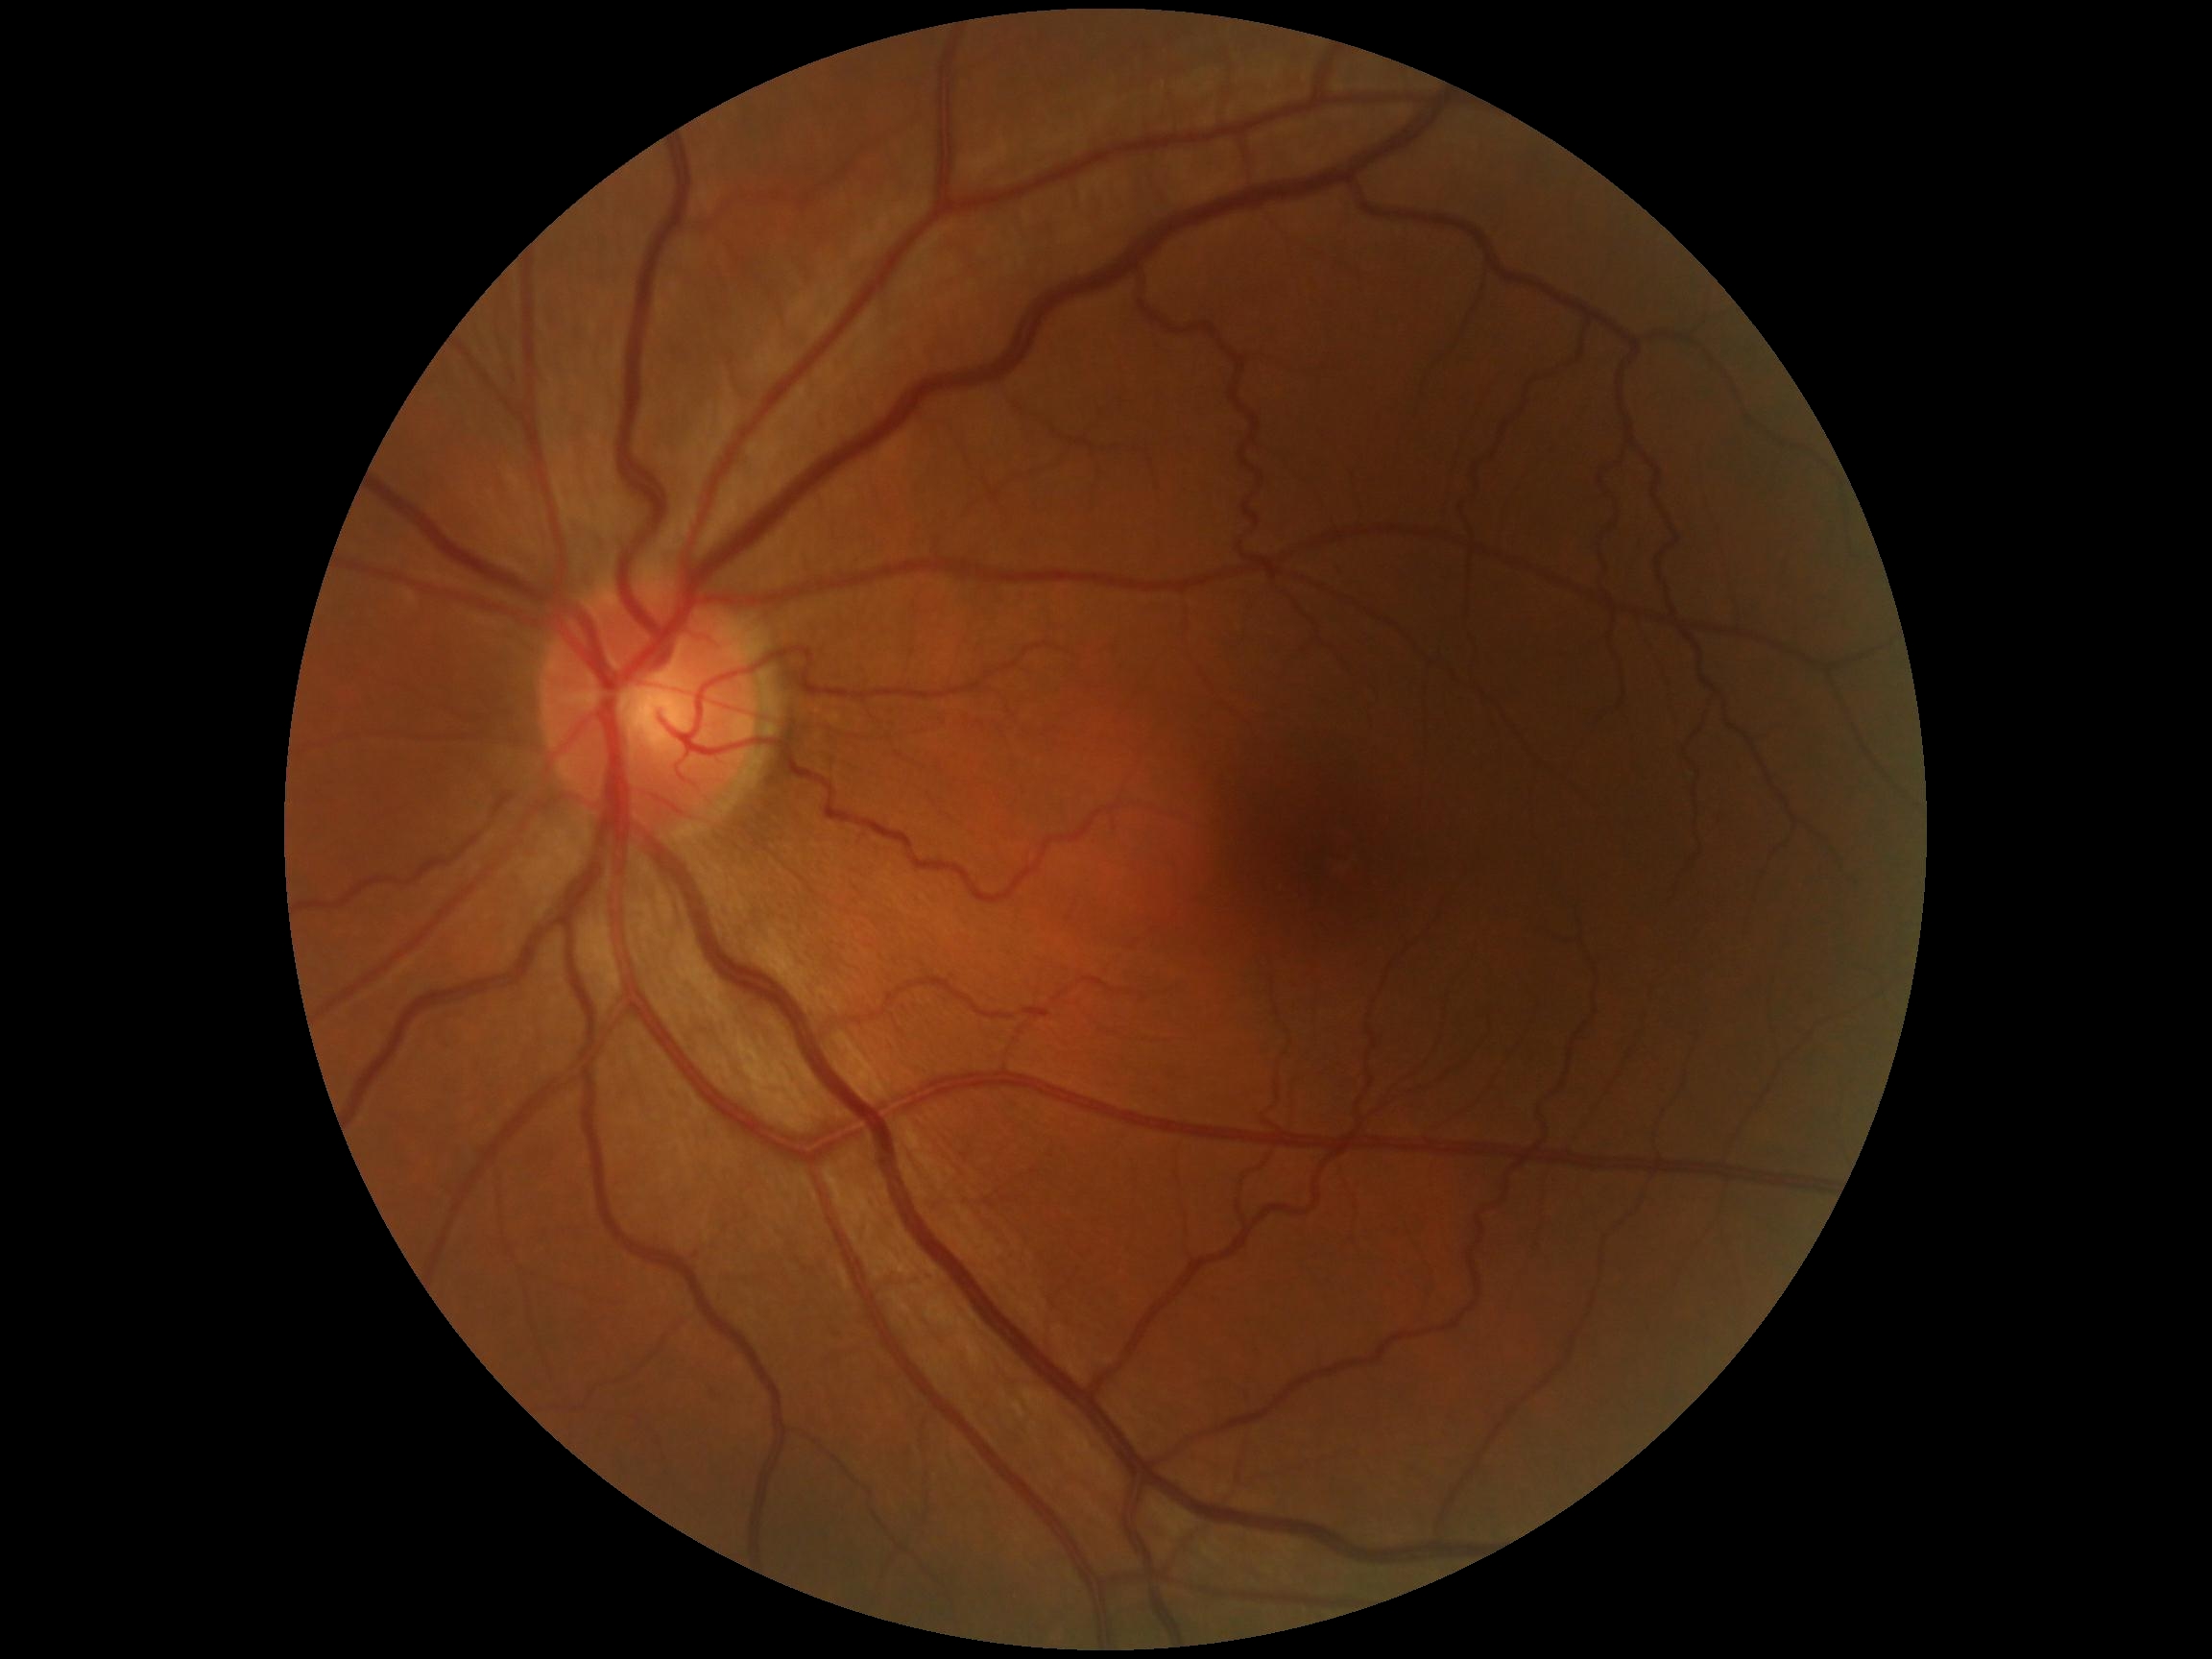

DR is 0/4. No signs of diabetic retinopathy.